No pharmacologic dilation · image size 848x848 · color fundus photograph · NIDEK AFC-230 · 45-degree field of view
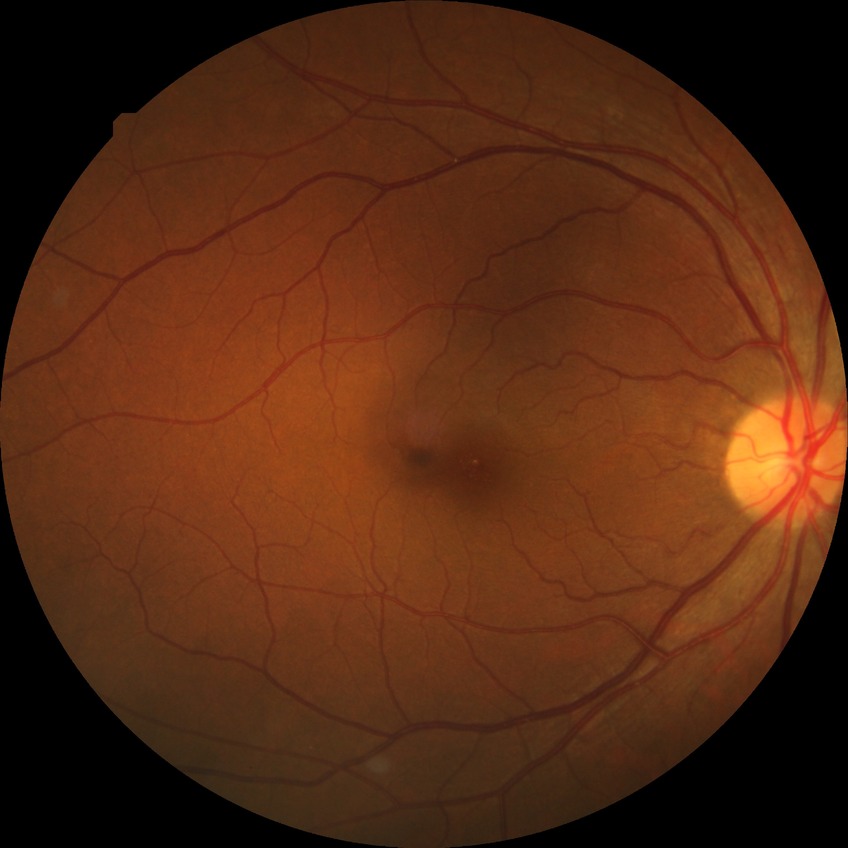
diabetic retinopathy (DR) = SDR (simple diabetic retinopathy)